Infant wide-field fundus photograph — 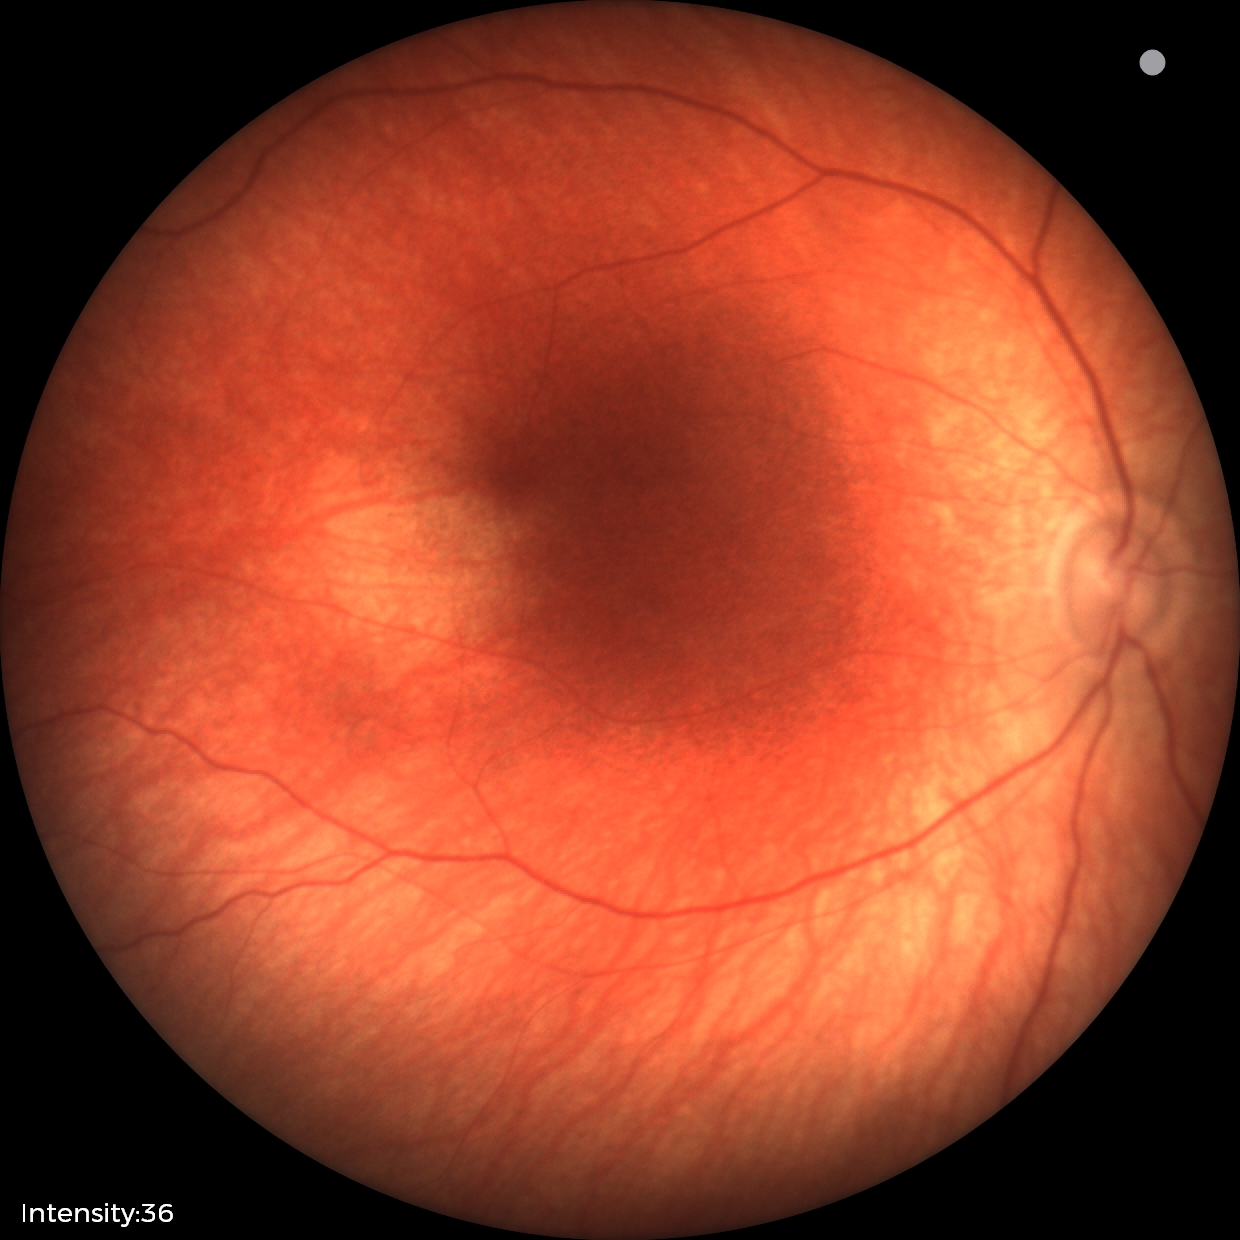
Screening examination diagnosed as physiological.